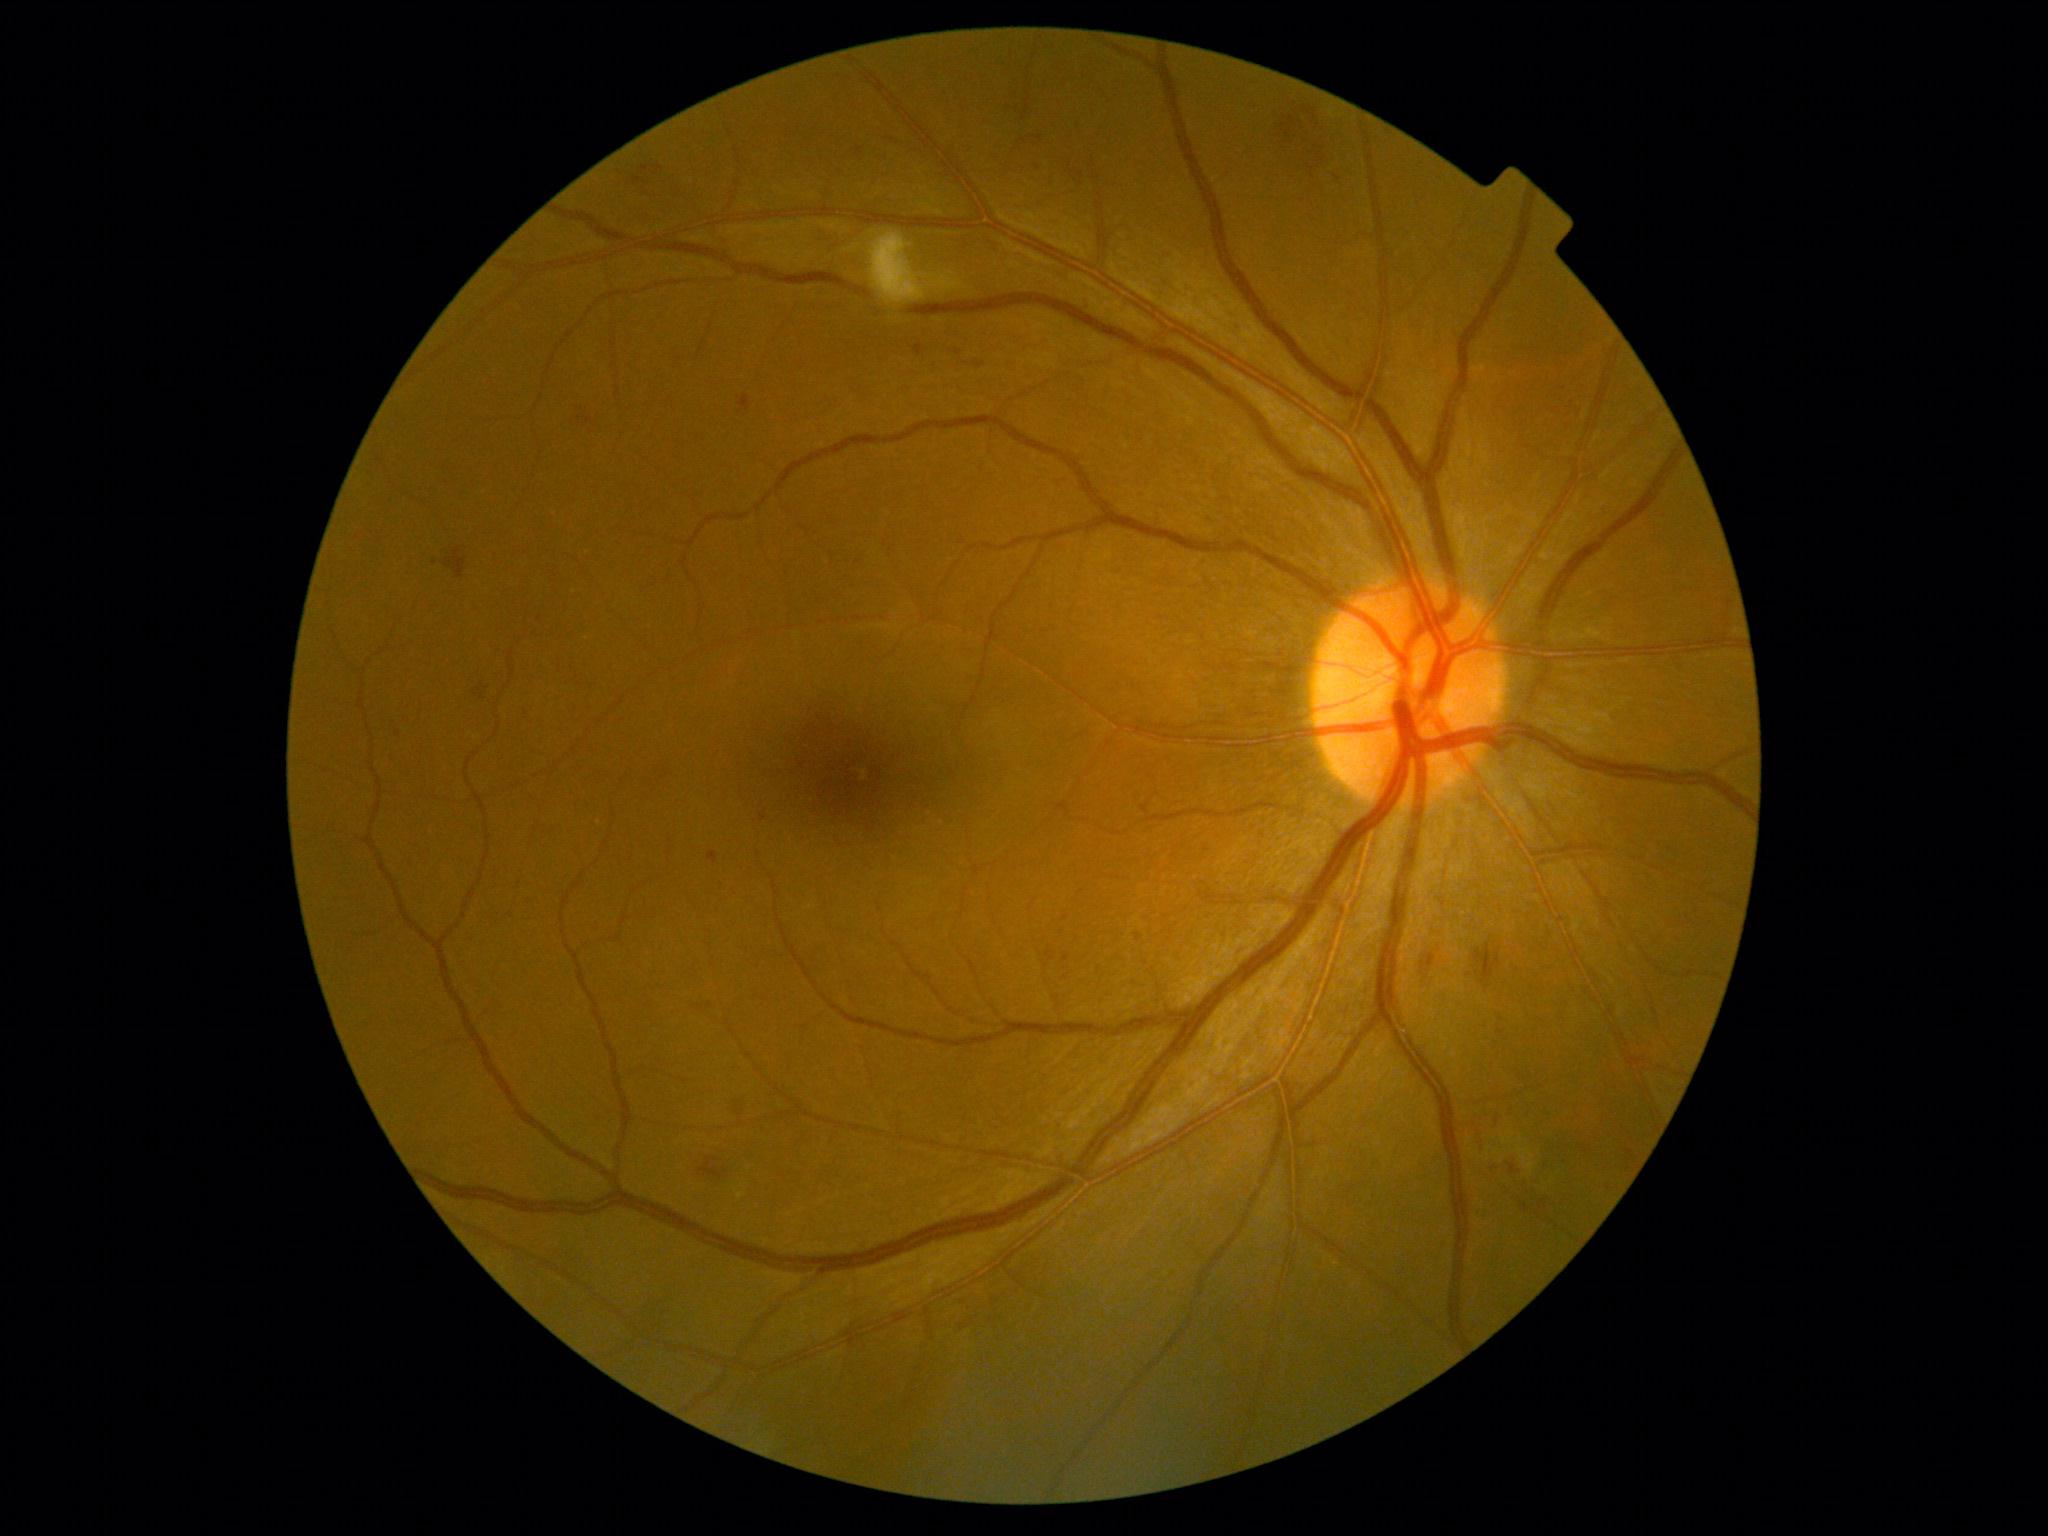
Diabetic retinopathy (DR) is 2
Selected lesions:
microaneurysms (MAs) (partial): 639 167 649 176 | 1141 805 1149 814 | 1539 1200 1546 1212 | 912 344 927 356 | 1510 1164 1516 1174 | 1522 1203 1529 1212 | 652 164 663 177 | 1424 947 1438 973 | 577 416 593 423
Small MAs near (1630,1153) | (1497,1121) | (1538,1215) | (959,353) | (435,563)